FOV: 45 degrees — 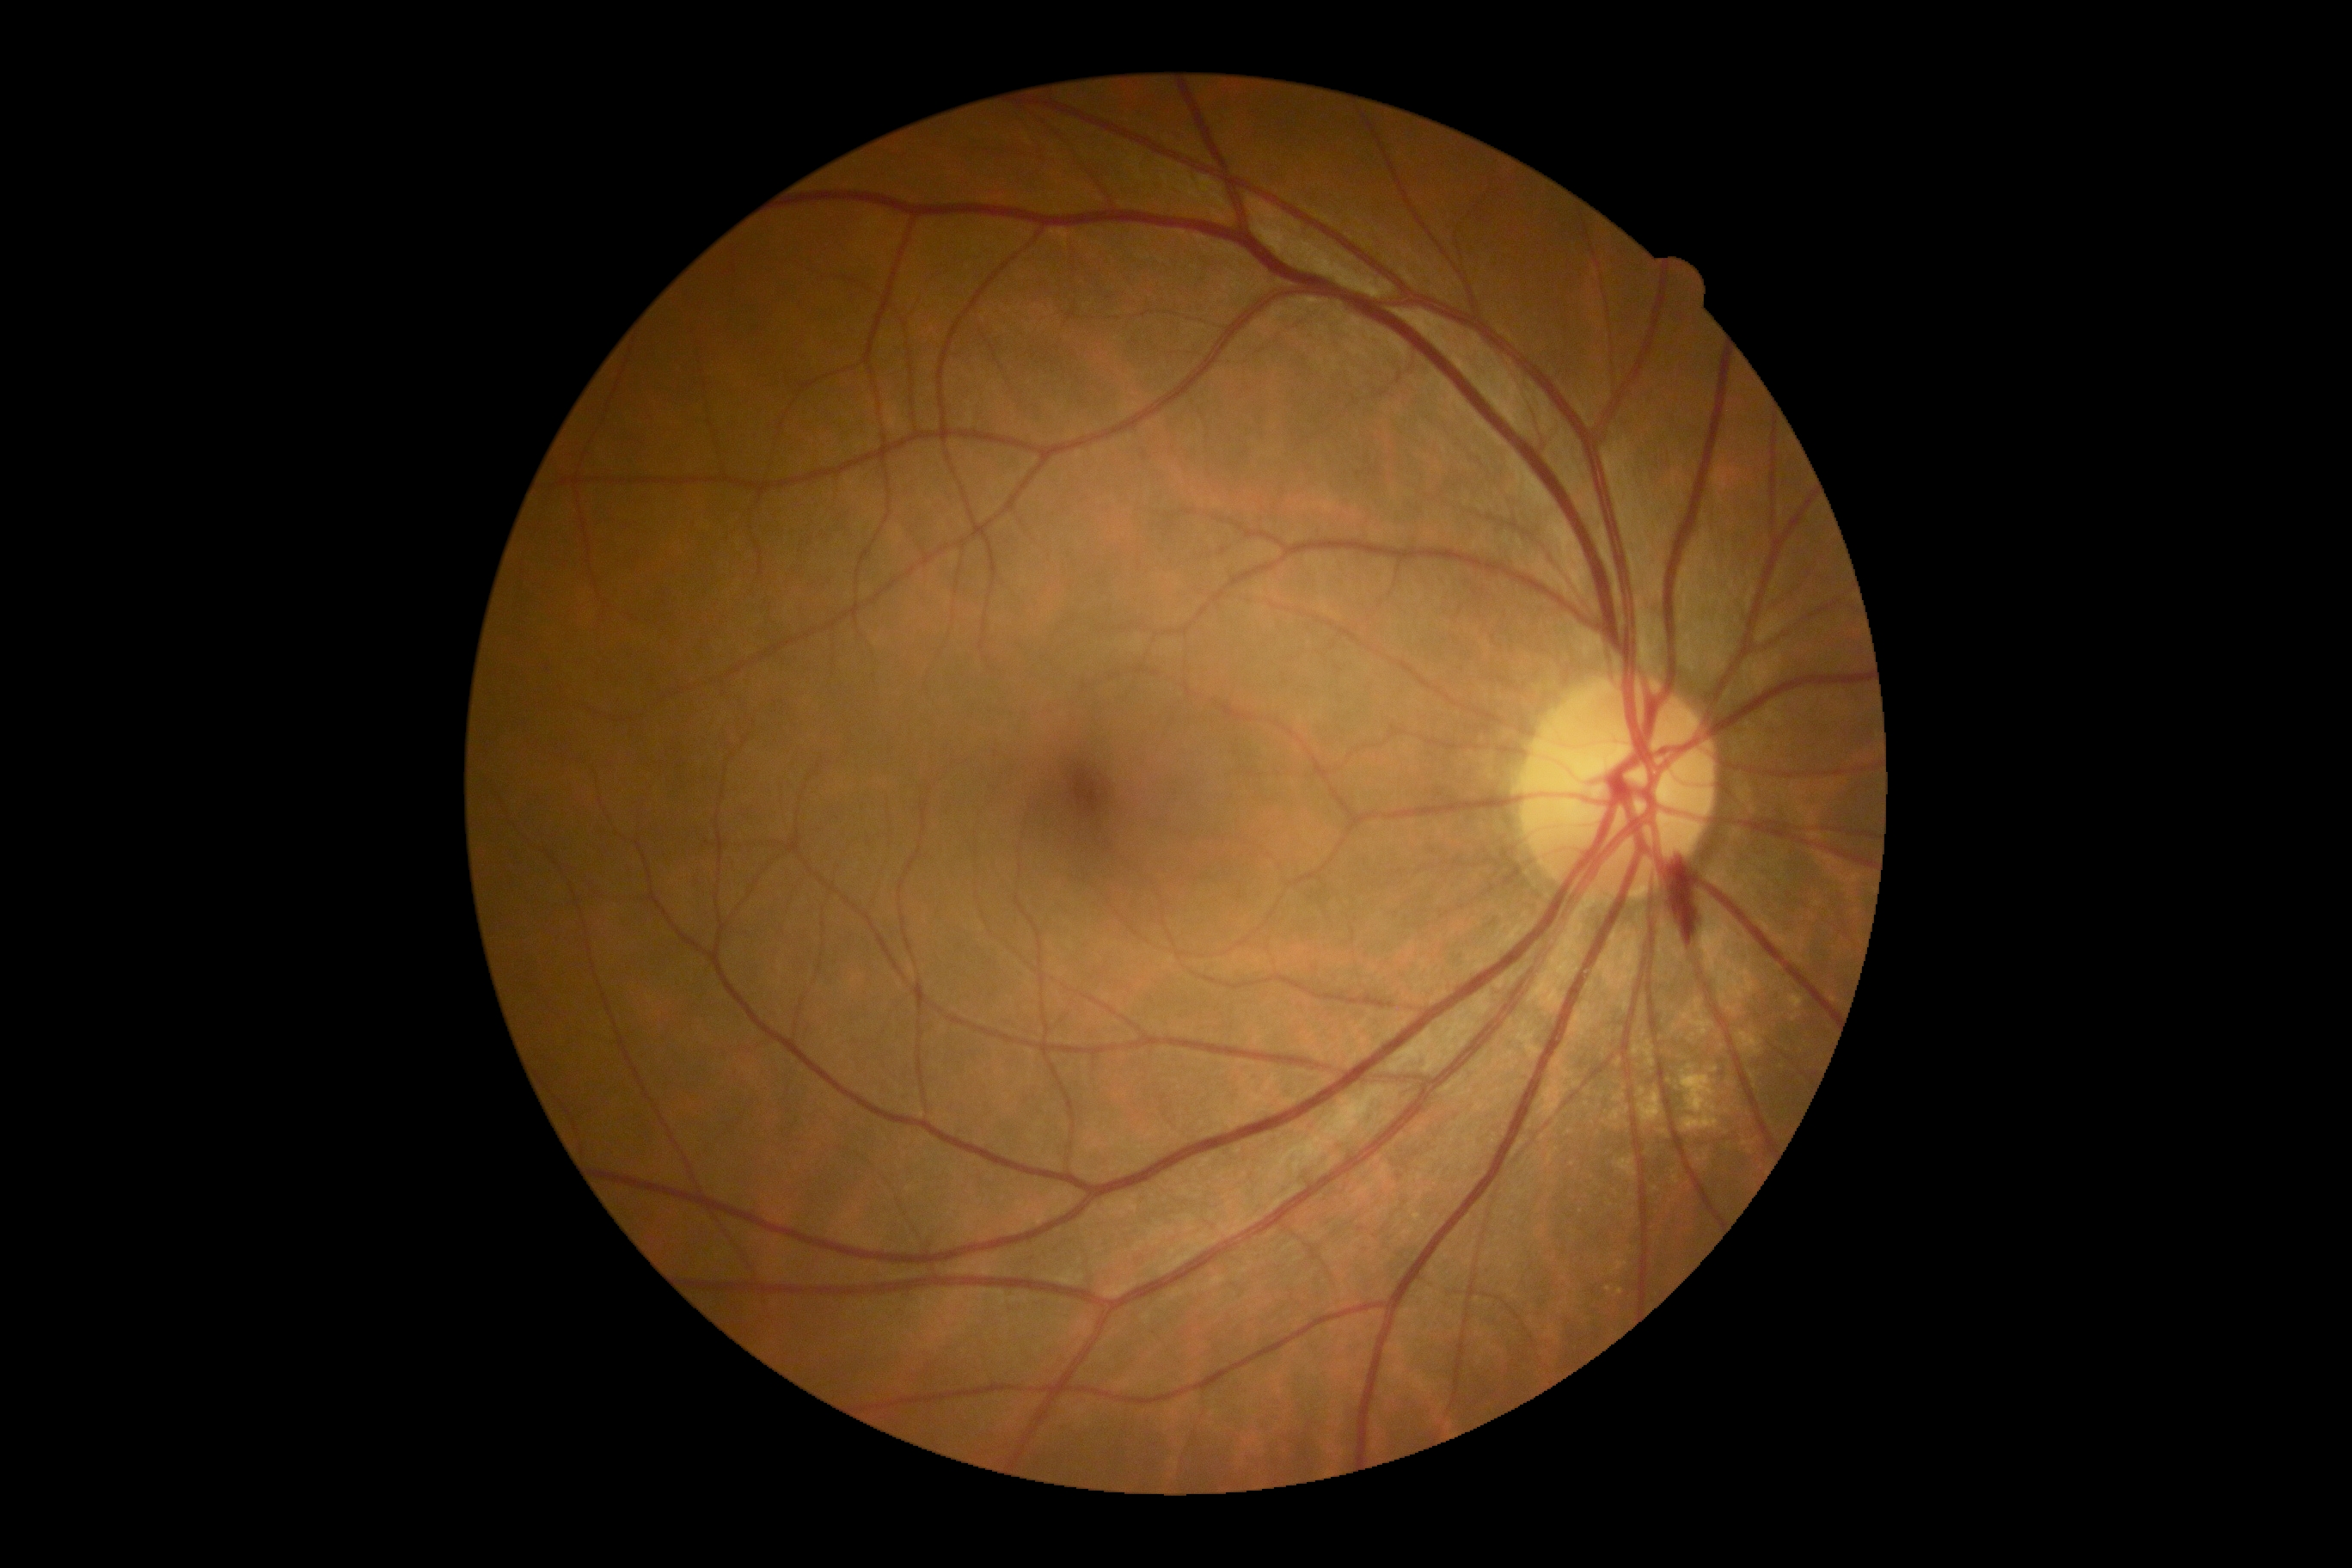
DR severity: grade 2 (moderate NPDR).